1240 by 1240 pixels. Camera: Phoenix ICON (100° FOV). Wide-field fundus photograph from neonatal ROP screening:
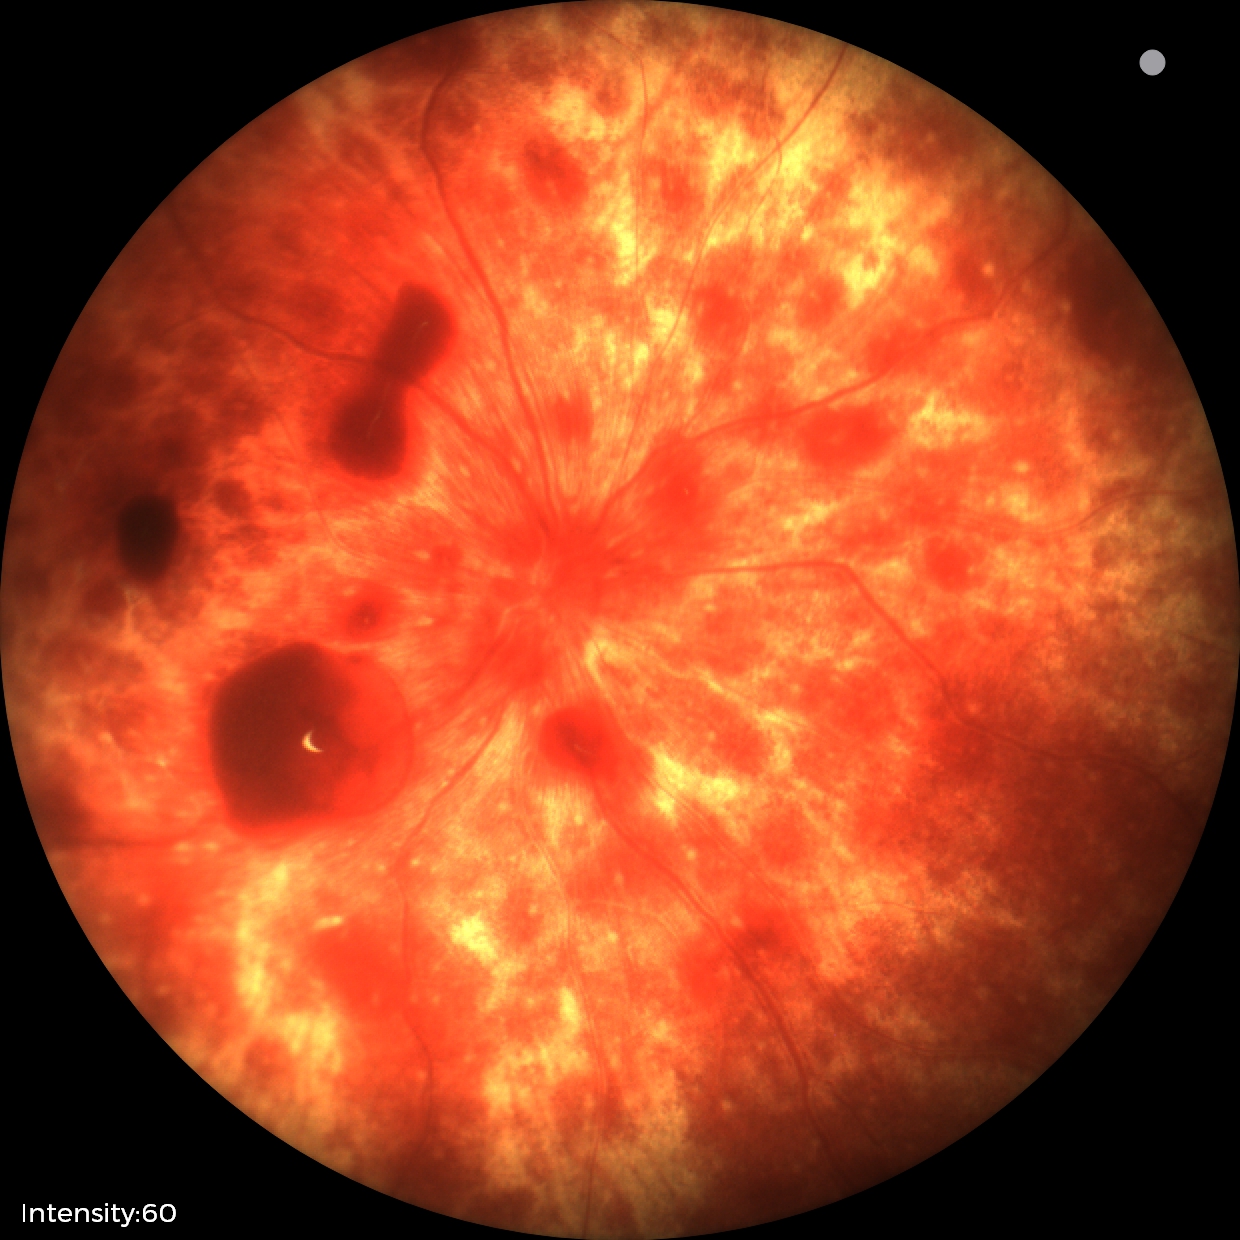
From an examination with diagnosis of retinal hemorrhages.